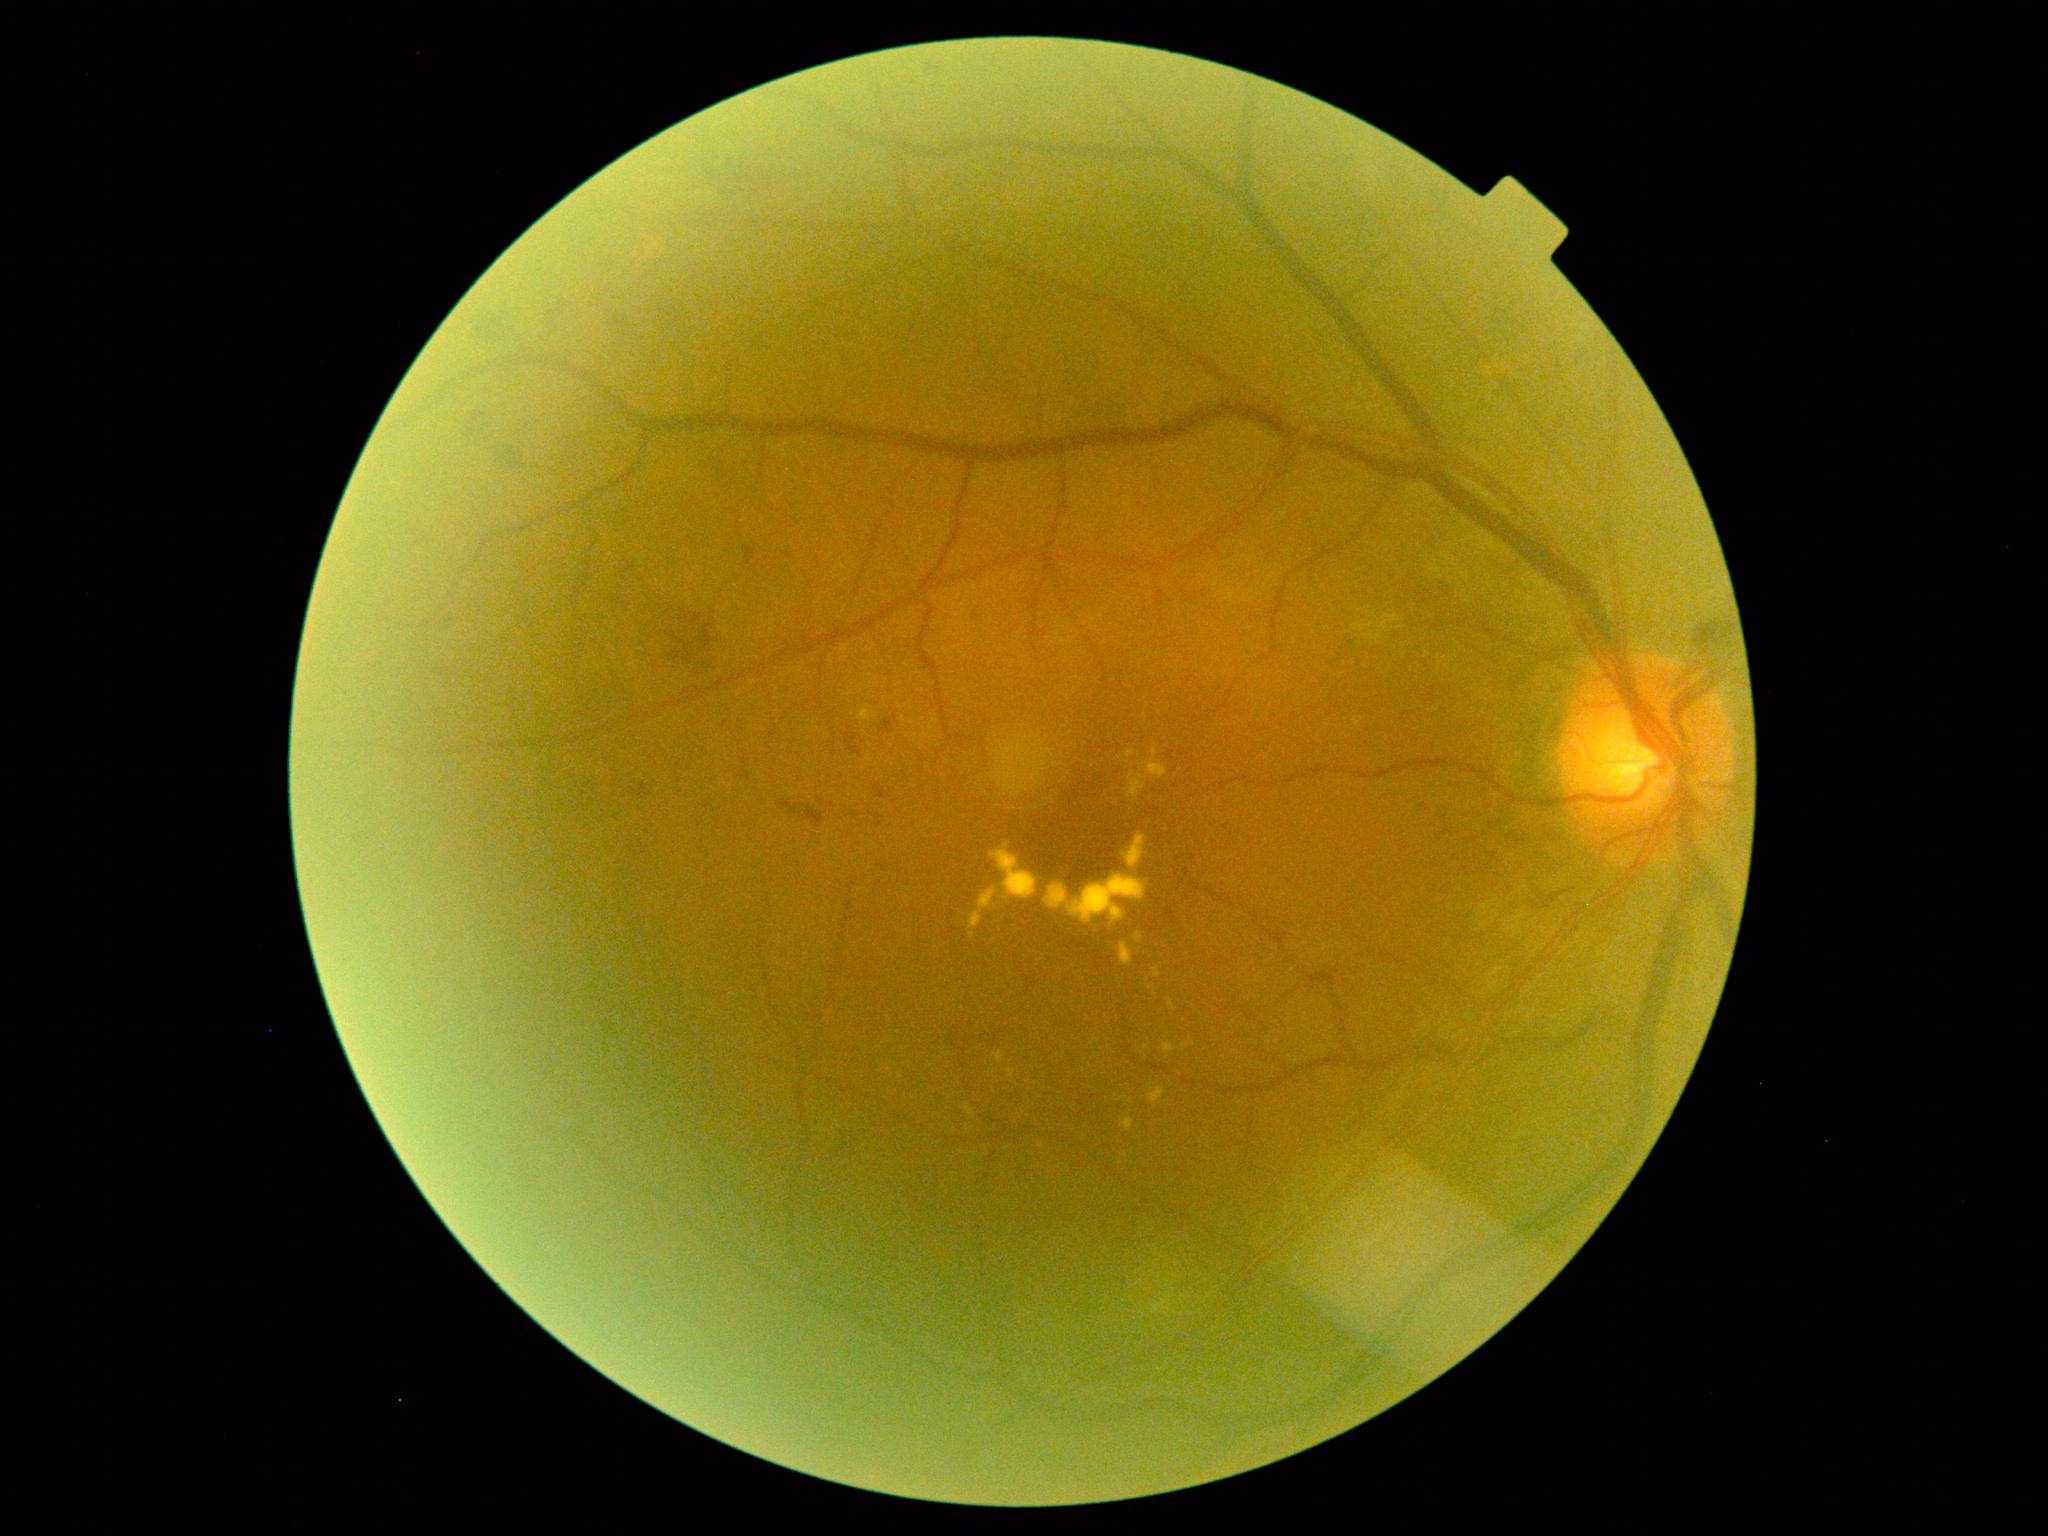   dr_category: non-proliferative diabetic retinopathy
  dr_grade: grade 2